Wide-field fundus photograph of an infant — 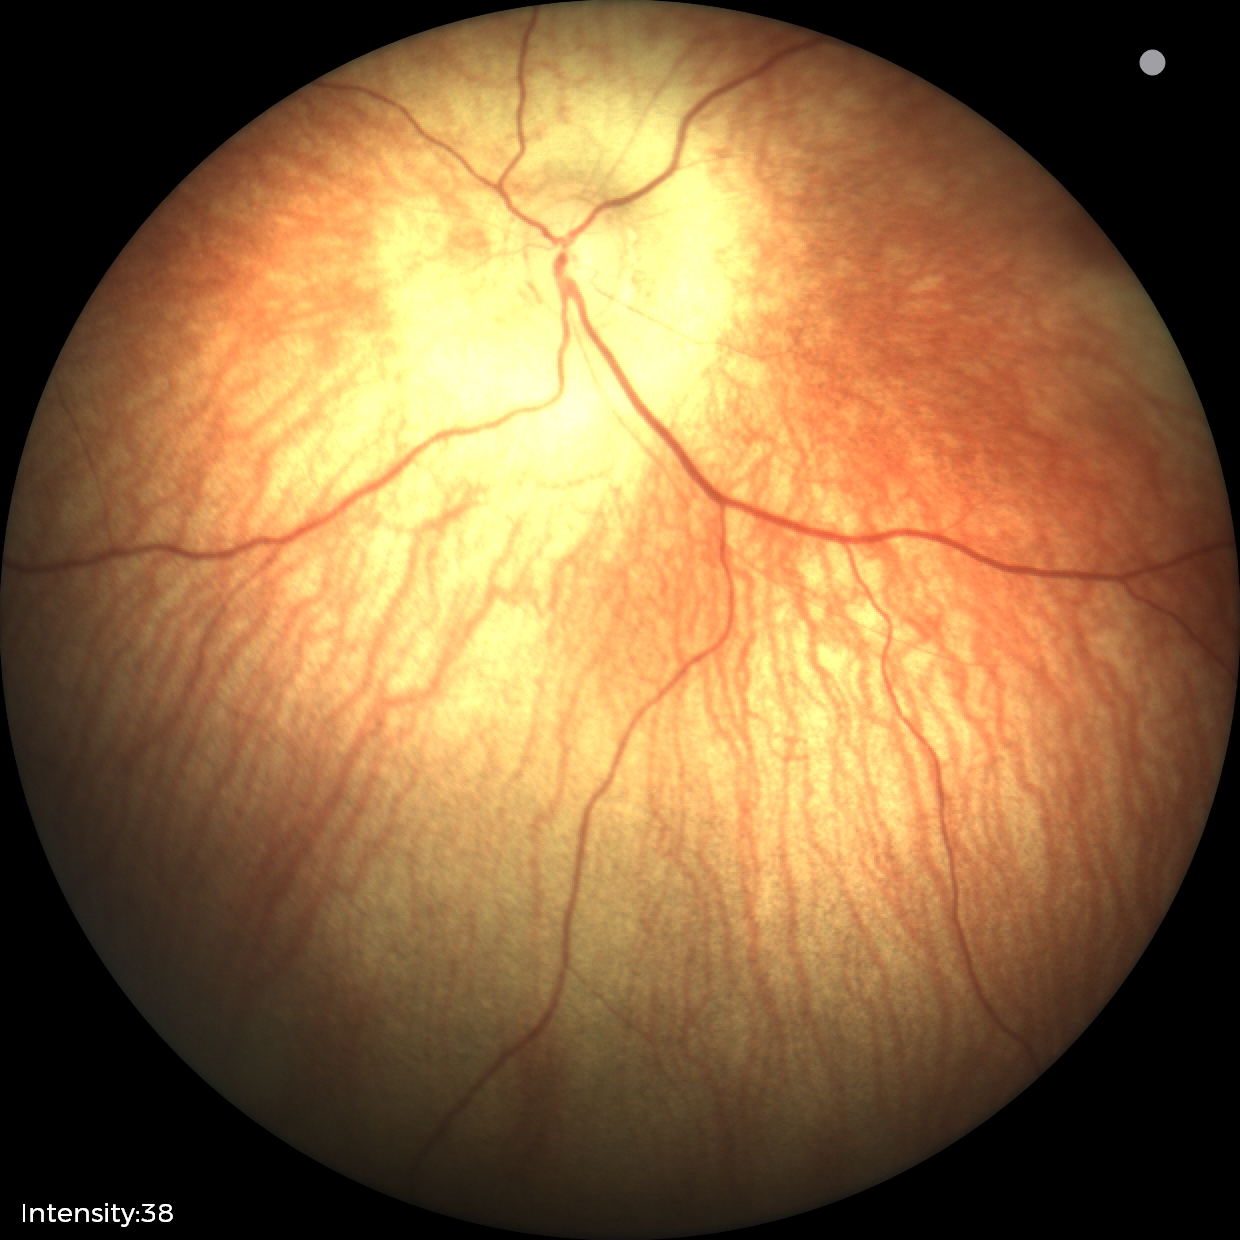
Assessment: no abnormalities.